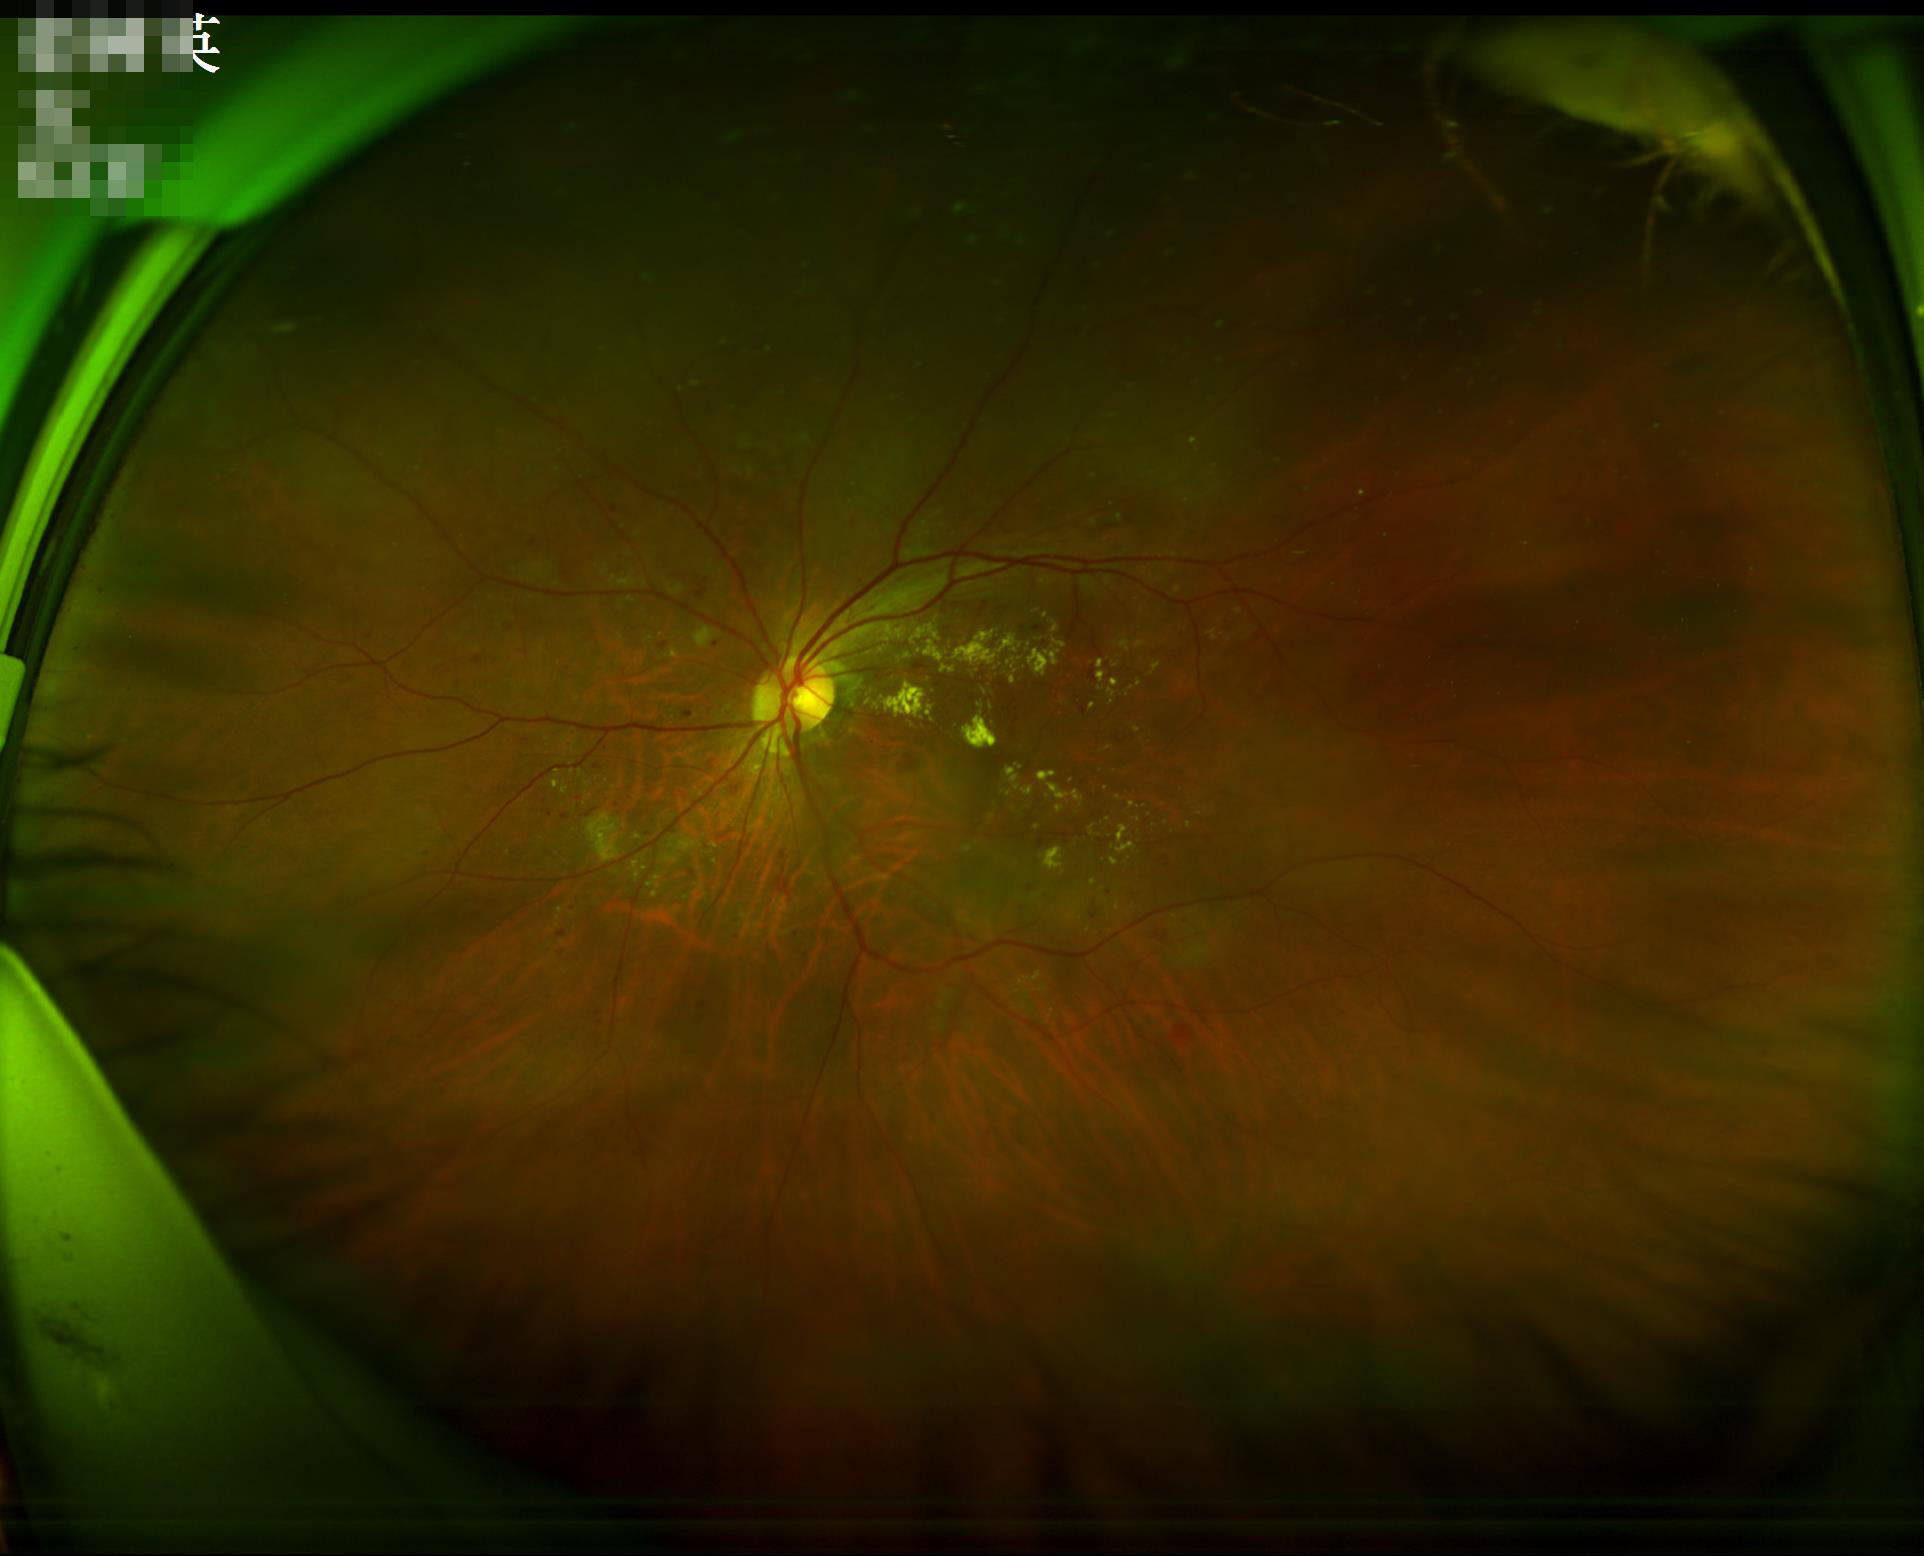
Image quality assessment: contrast: vessels and details readily distinguishable | sharpness: sharp throughout the field | overall: good, gradable.